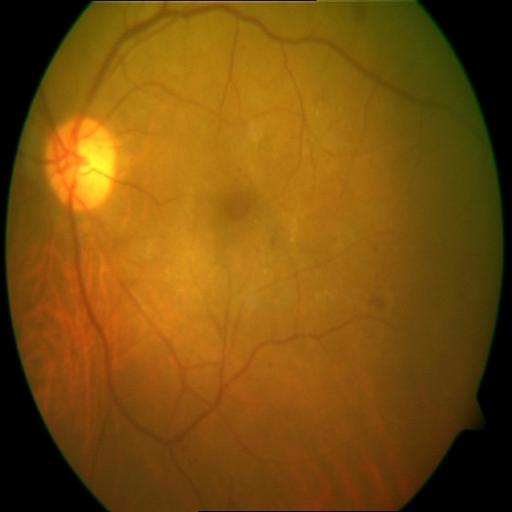
Fundus image with findings of hemorrhagic retinopathy (HR) and cystoid macular edema (CME).